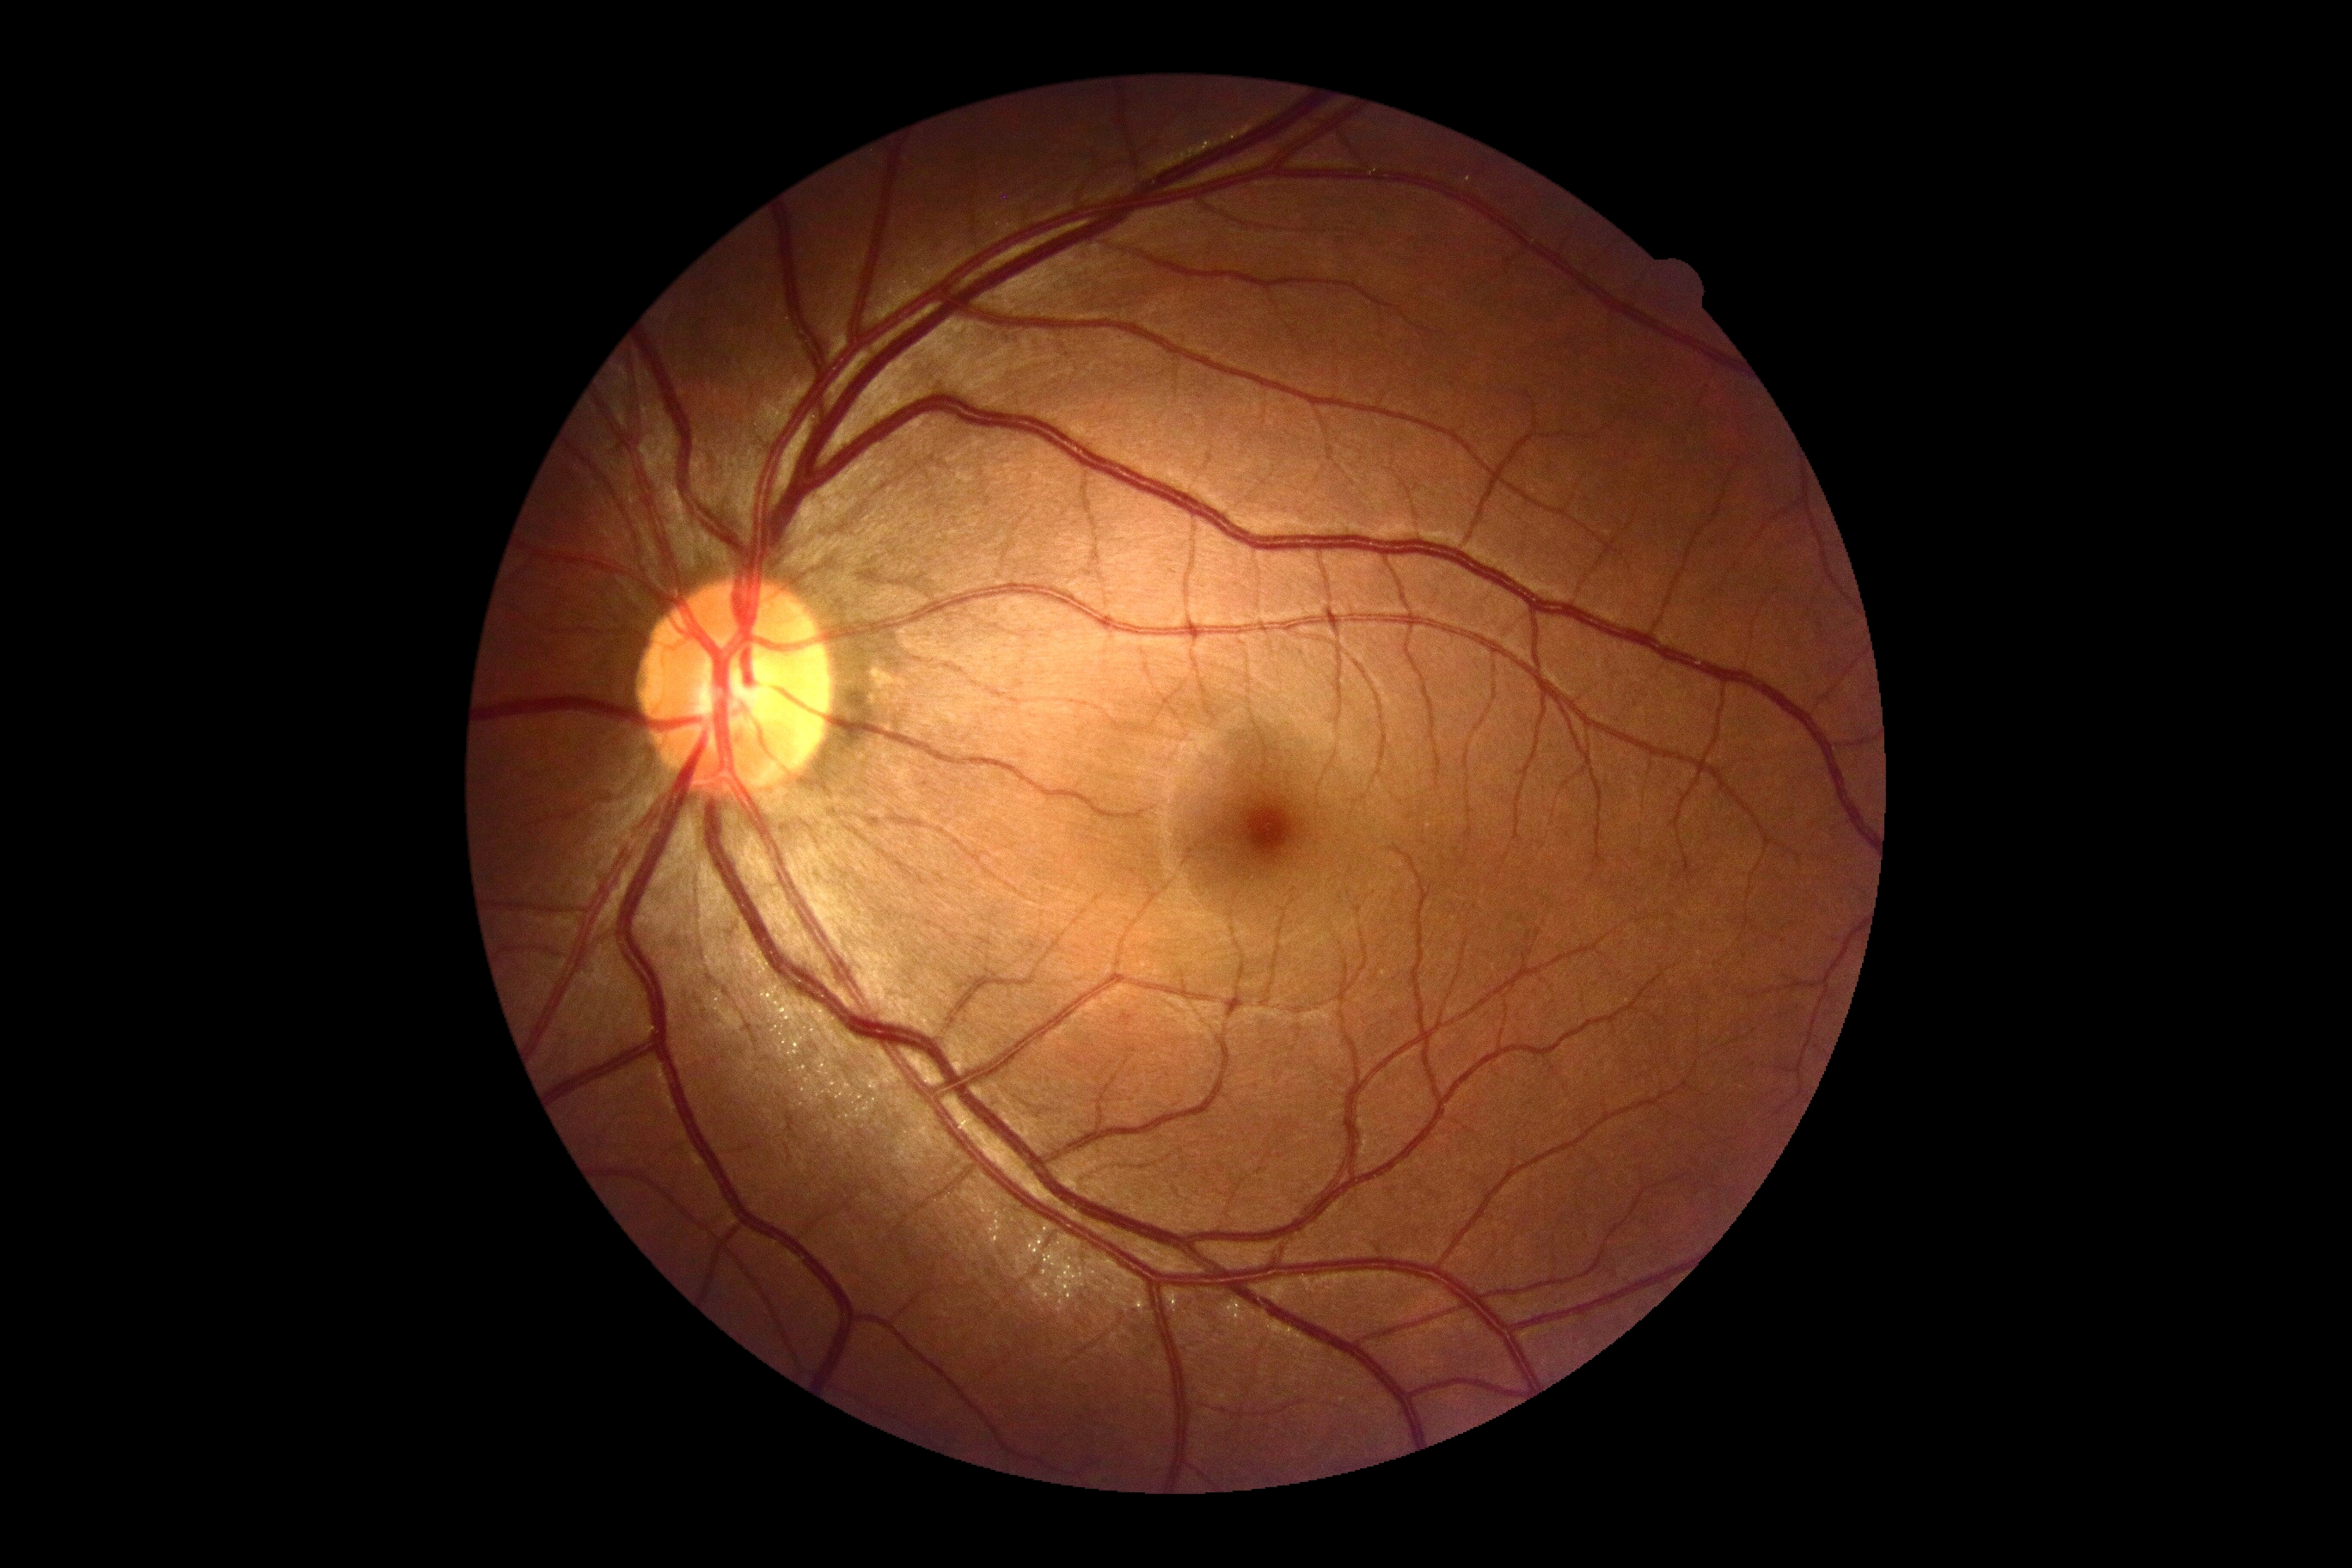

retinopathy grade = 0/4.